2352 x 1568 pixels — 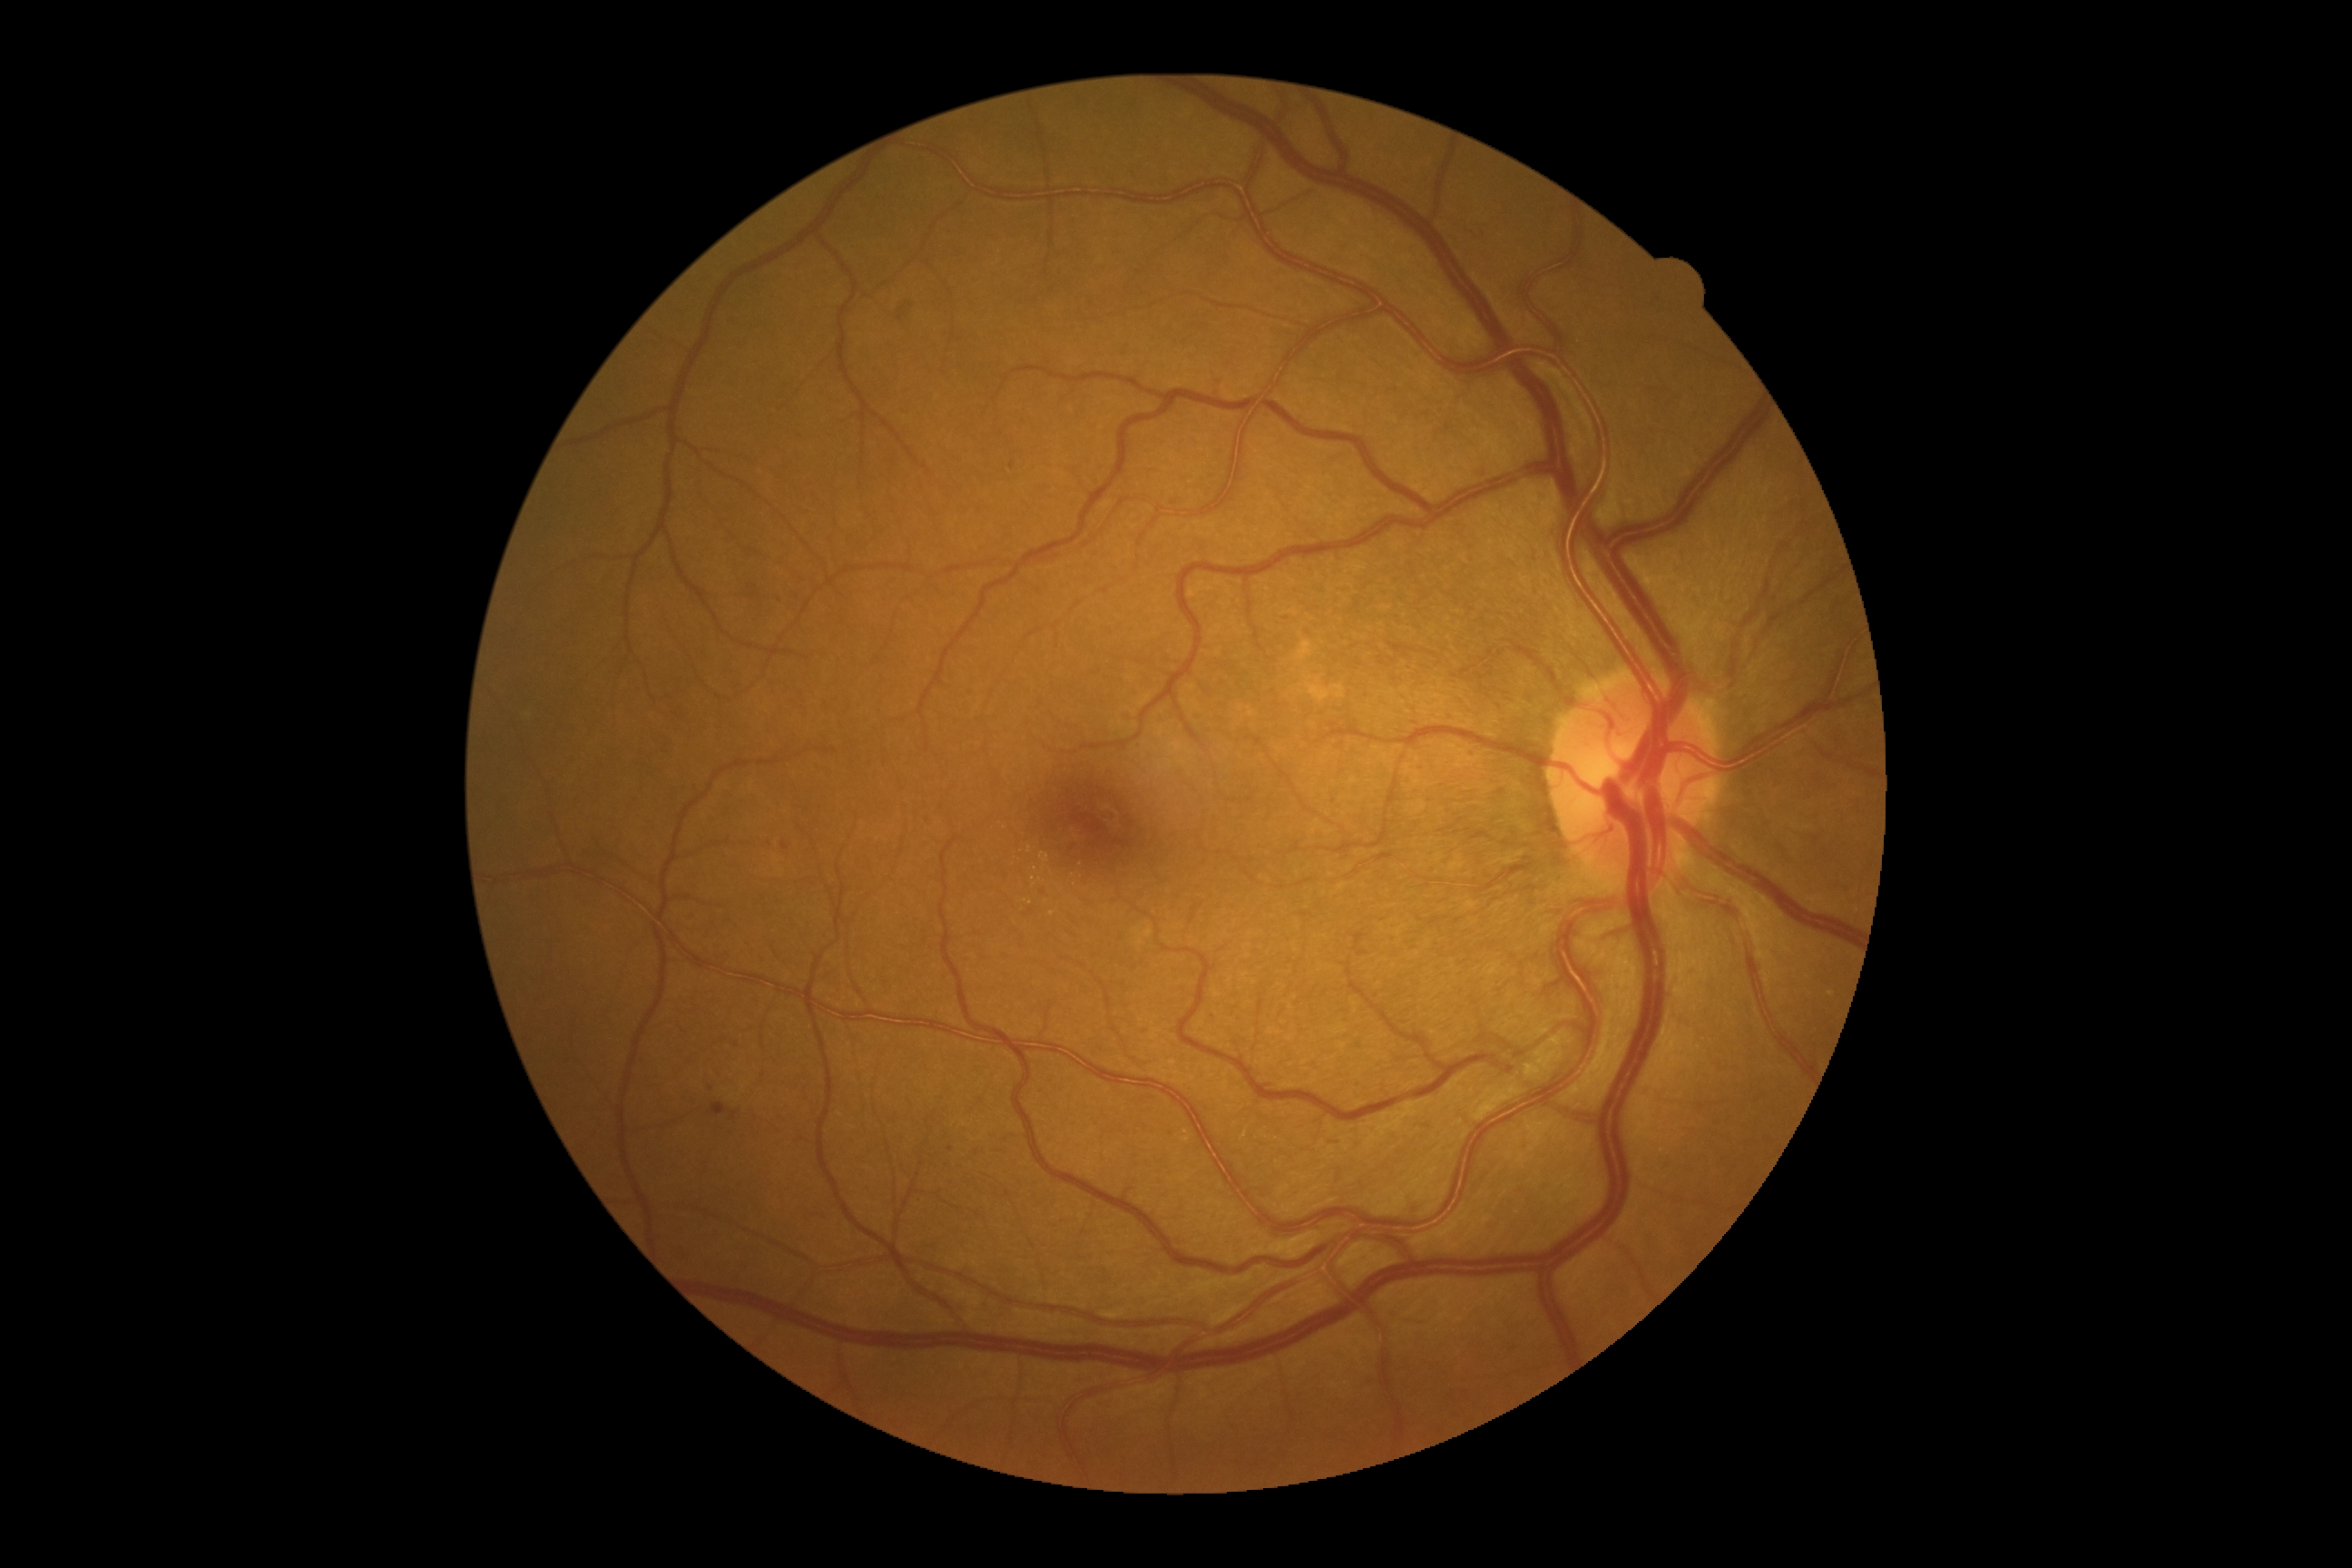

The retinopathy is classified as non-proliferative diabetic retinopathy. DR is 2.